412 x 310 pixels; fundus photo:
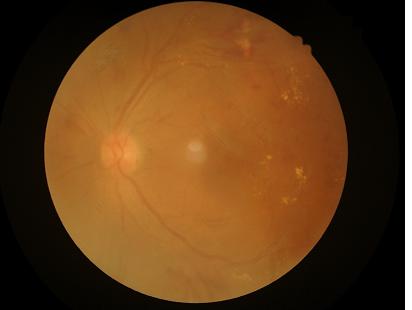

Quality grading: illumination/color: satisfactory | overall: low | contrast: low | focus: reduced.